CFP, centered on the optic disc — 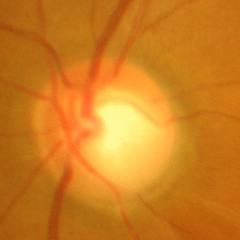 Q: Does this eye have glaucoma?
A: Yes — advanced glaucoma.